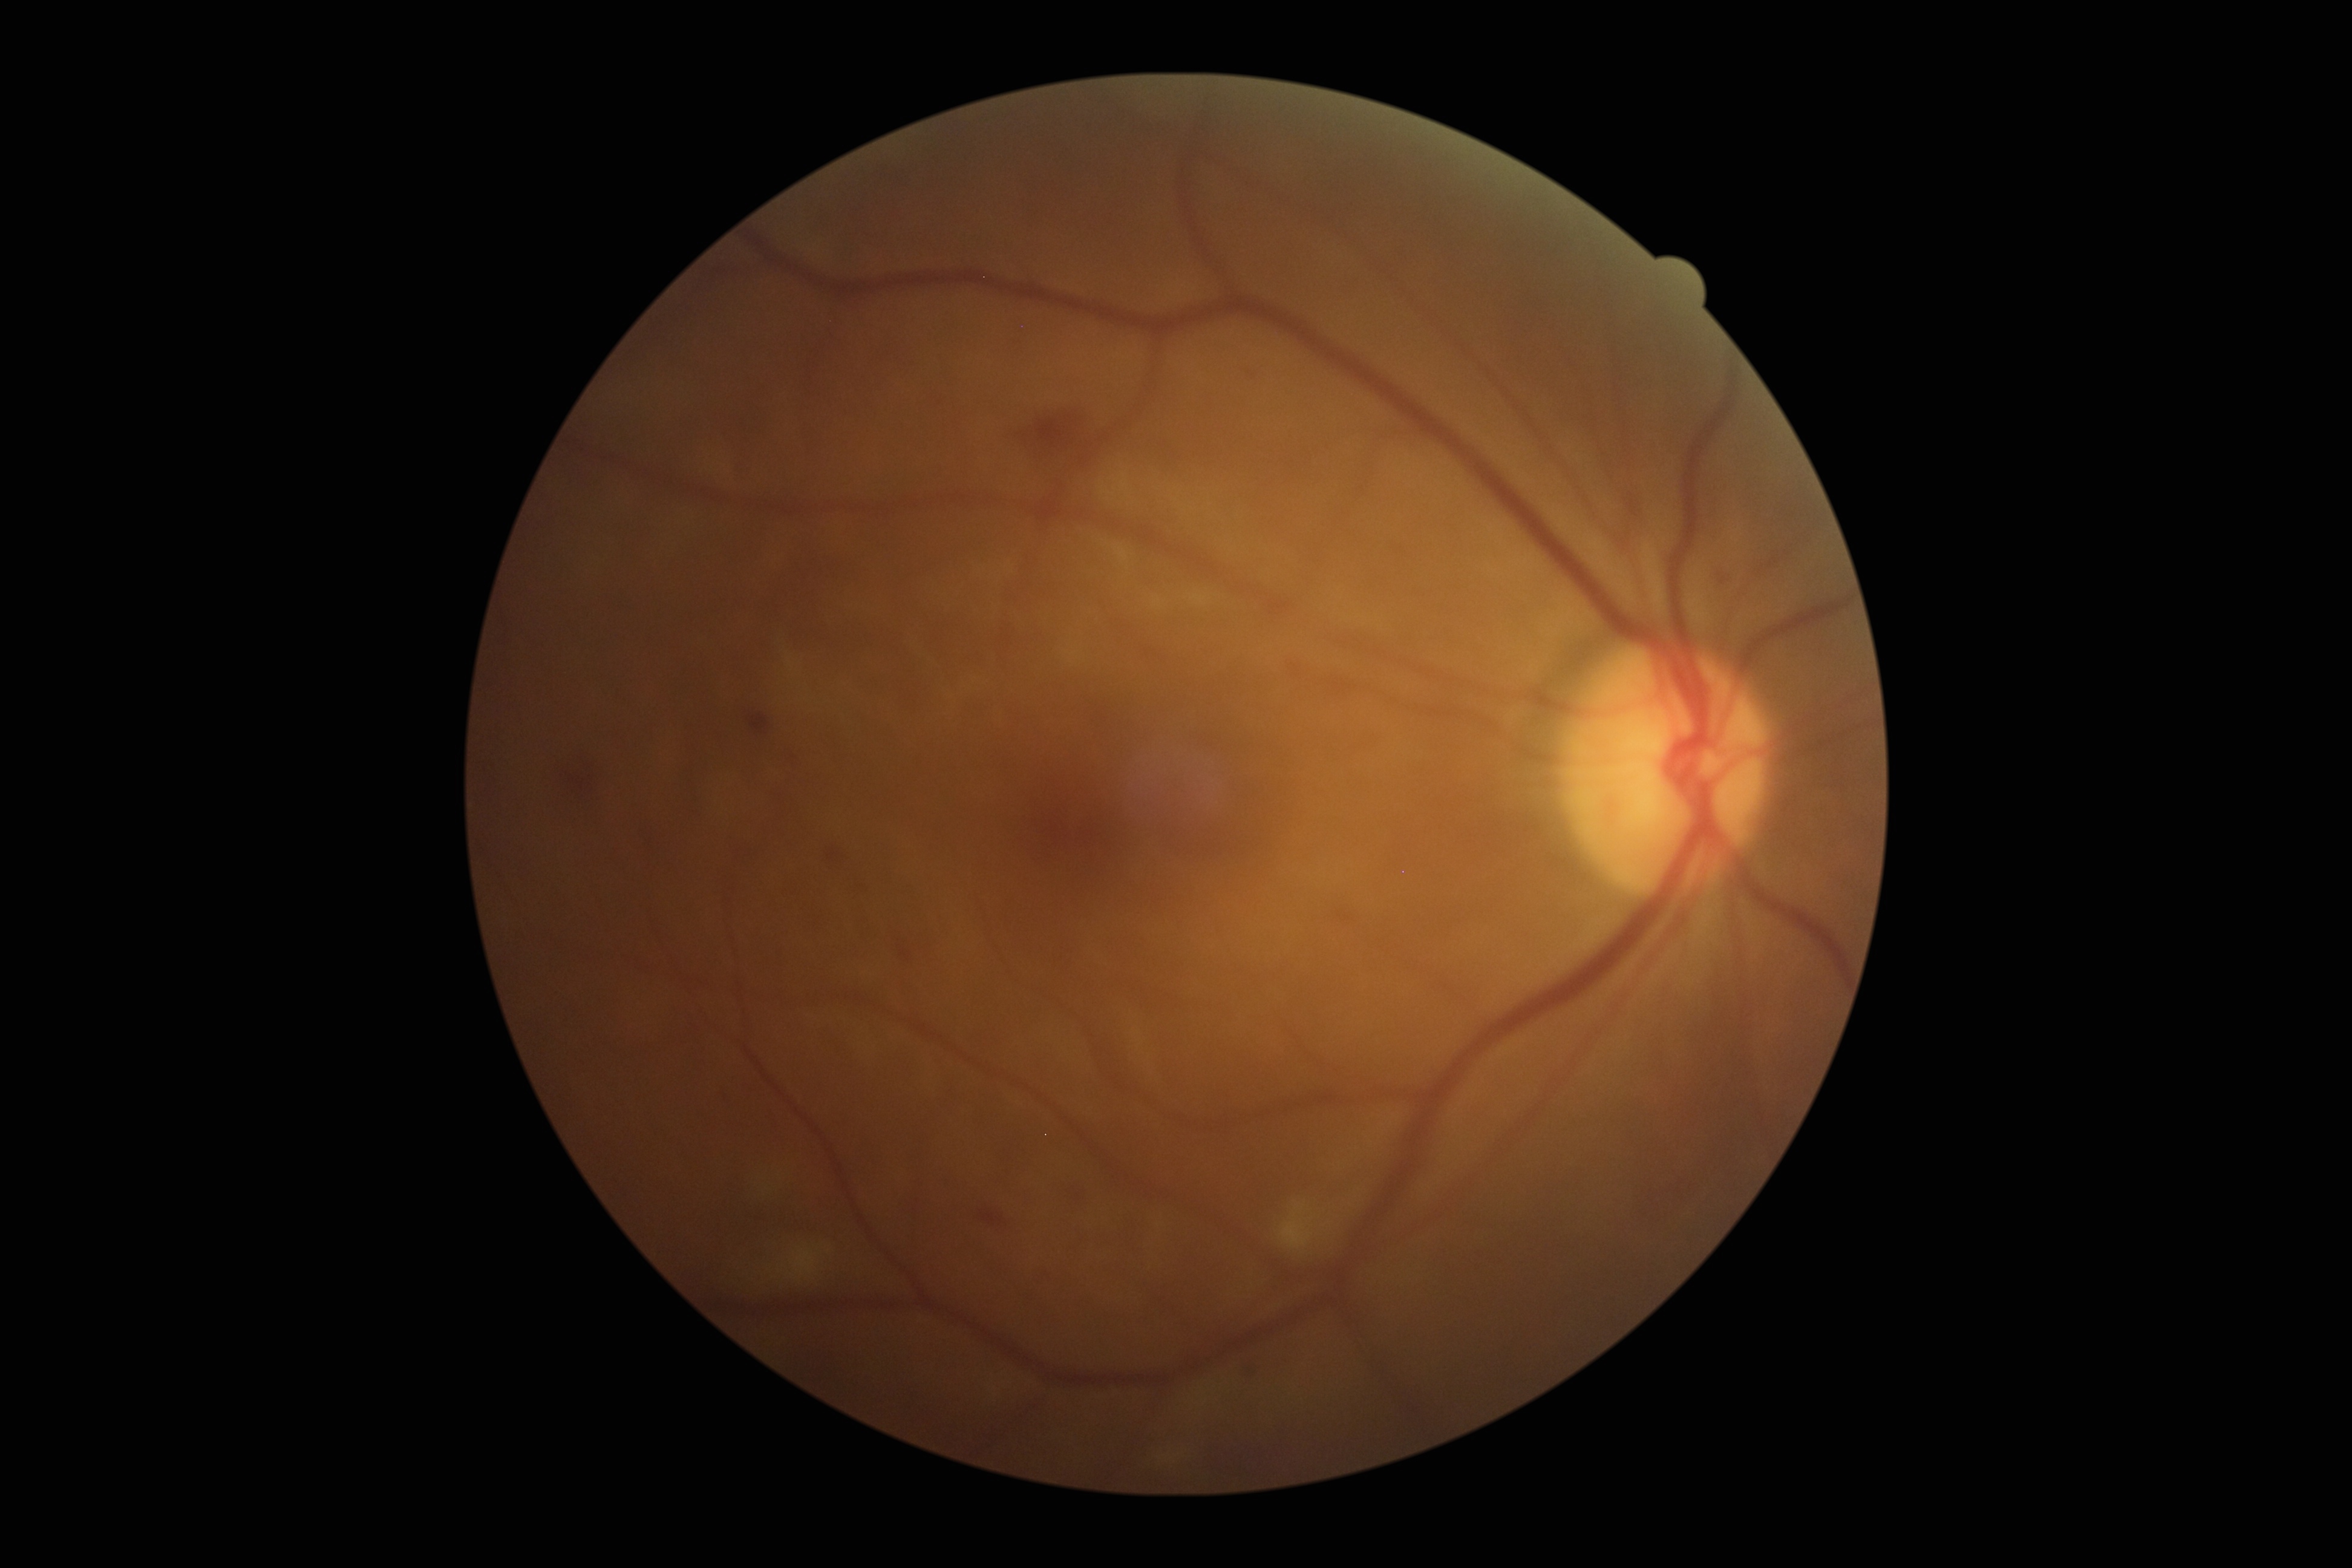
Retinopathy is grade 2 (moderate NPDR).